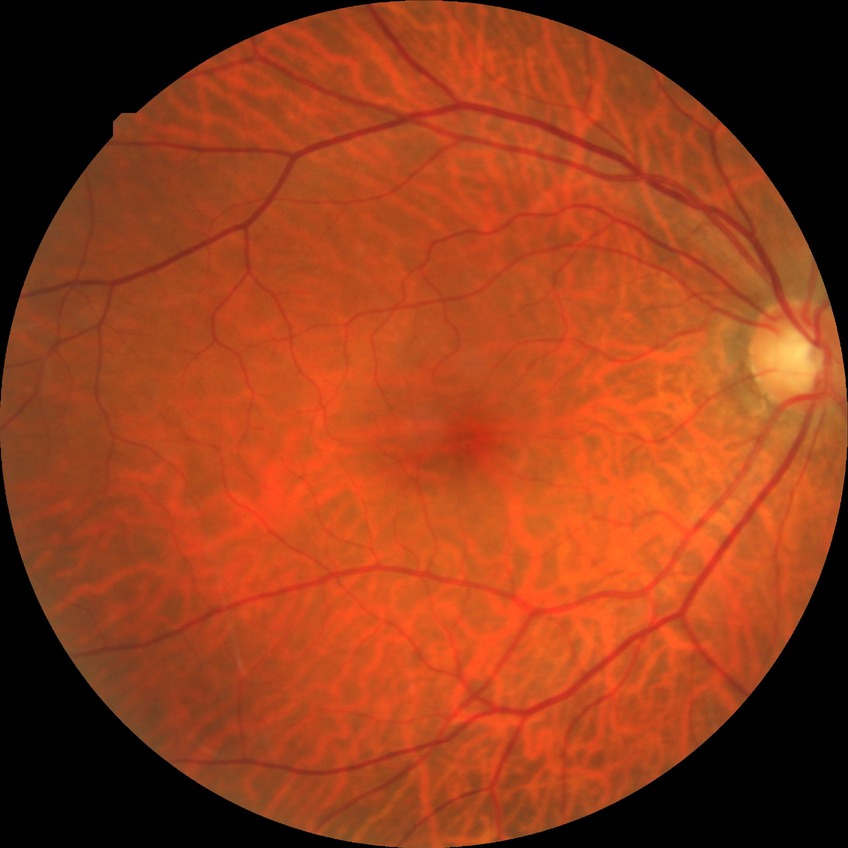 Diabetic retinopathy (DR): no diabetic retinopathy (NDR).